Natus RetCam Envision, 130° FOV · image size 1440x1080 · wide-field fundus image from infant ROP screening — 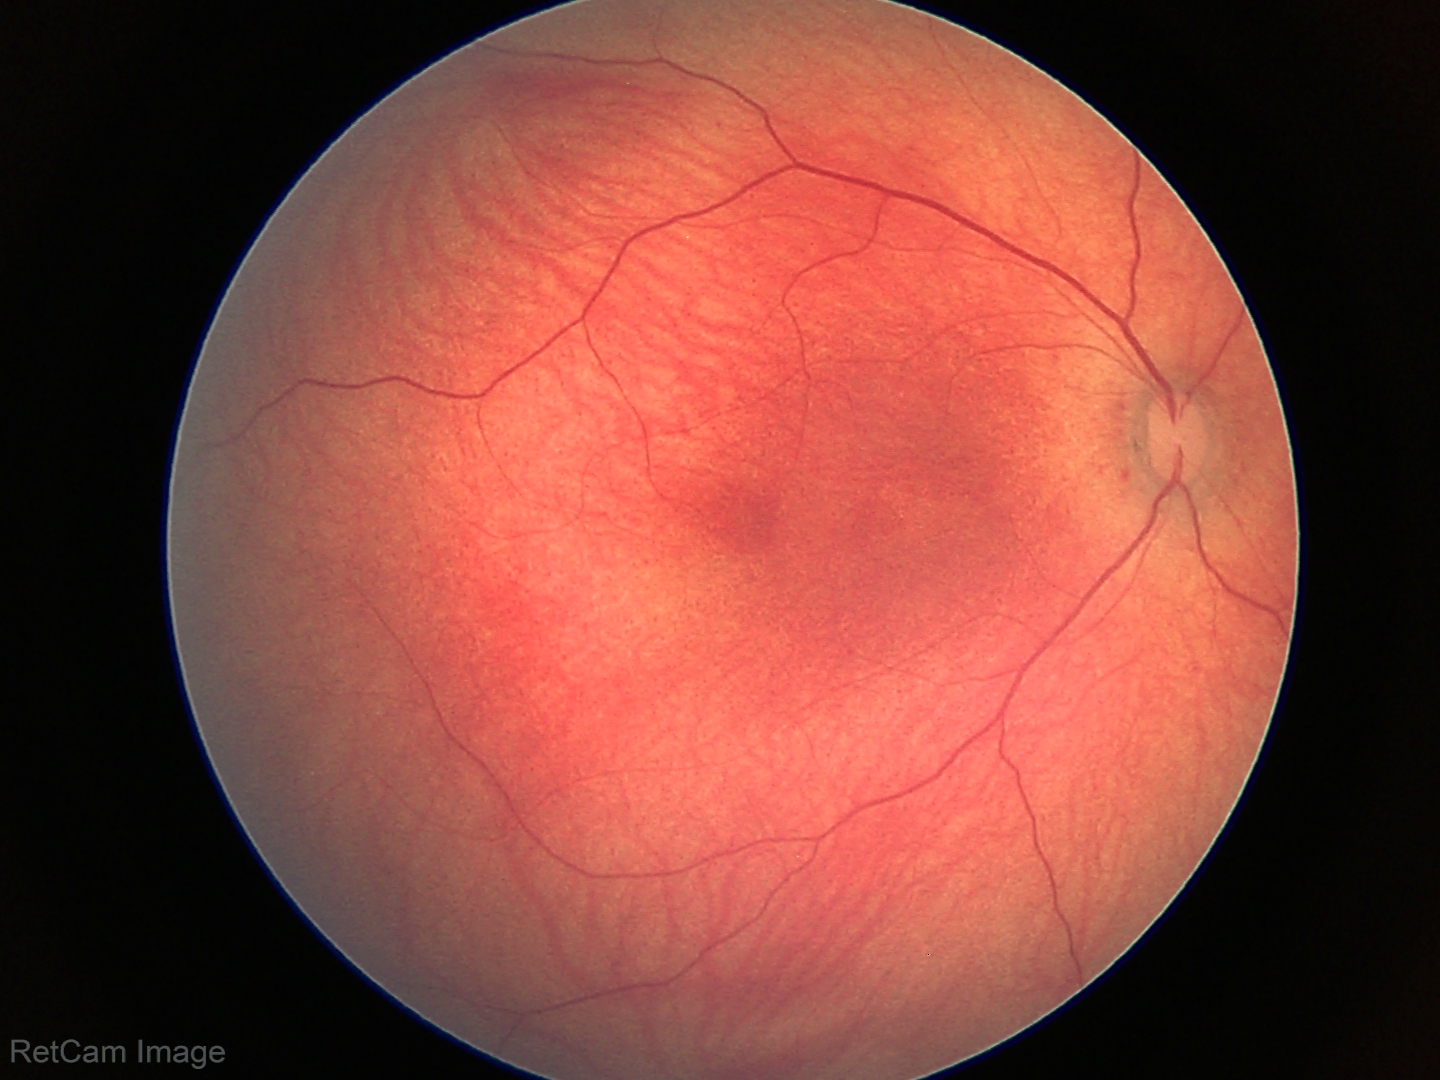 Normal screening examination.